2352x1568: 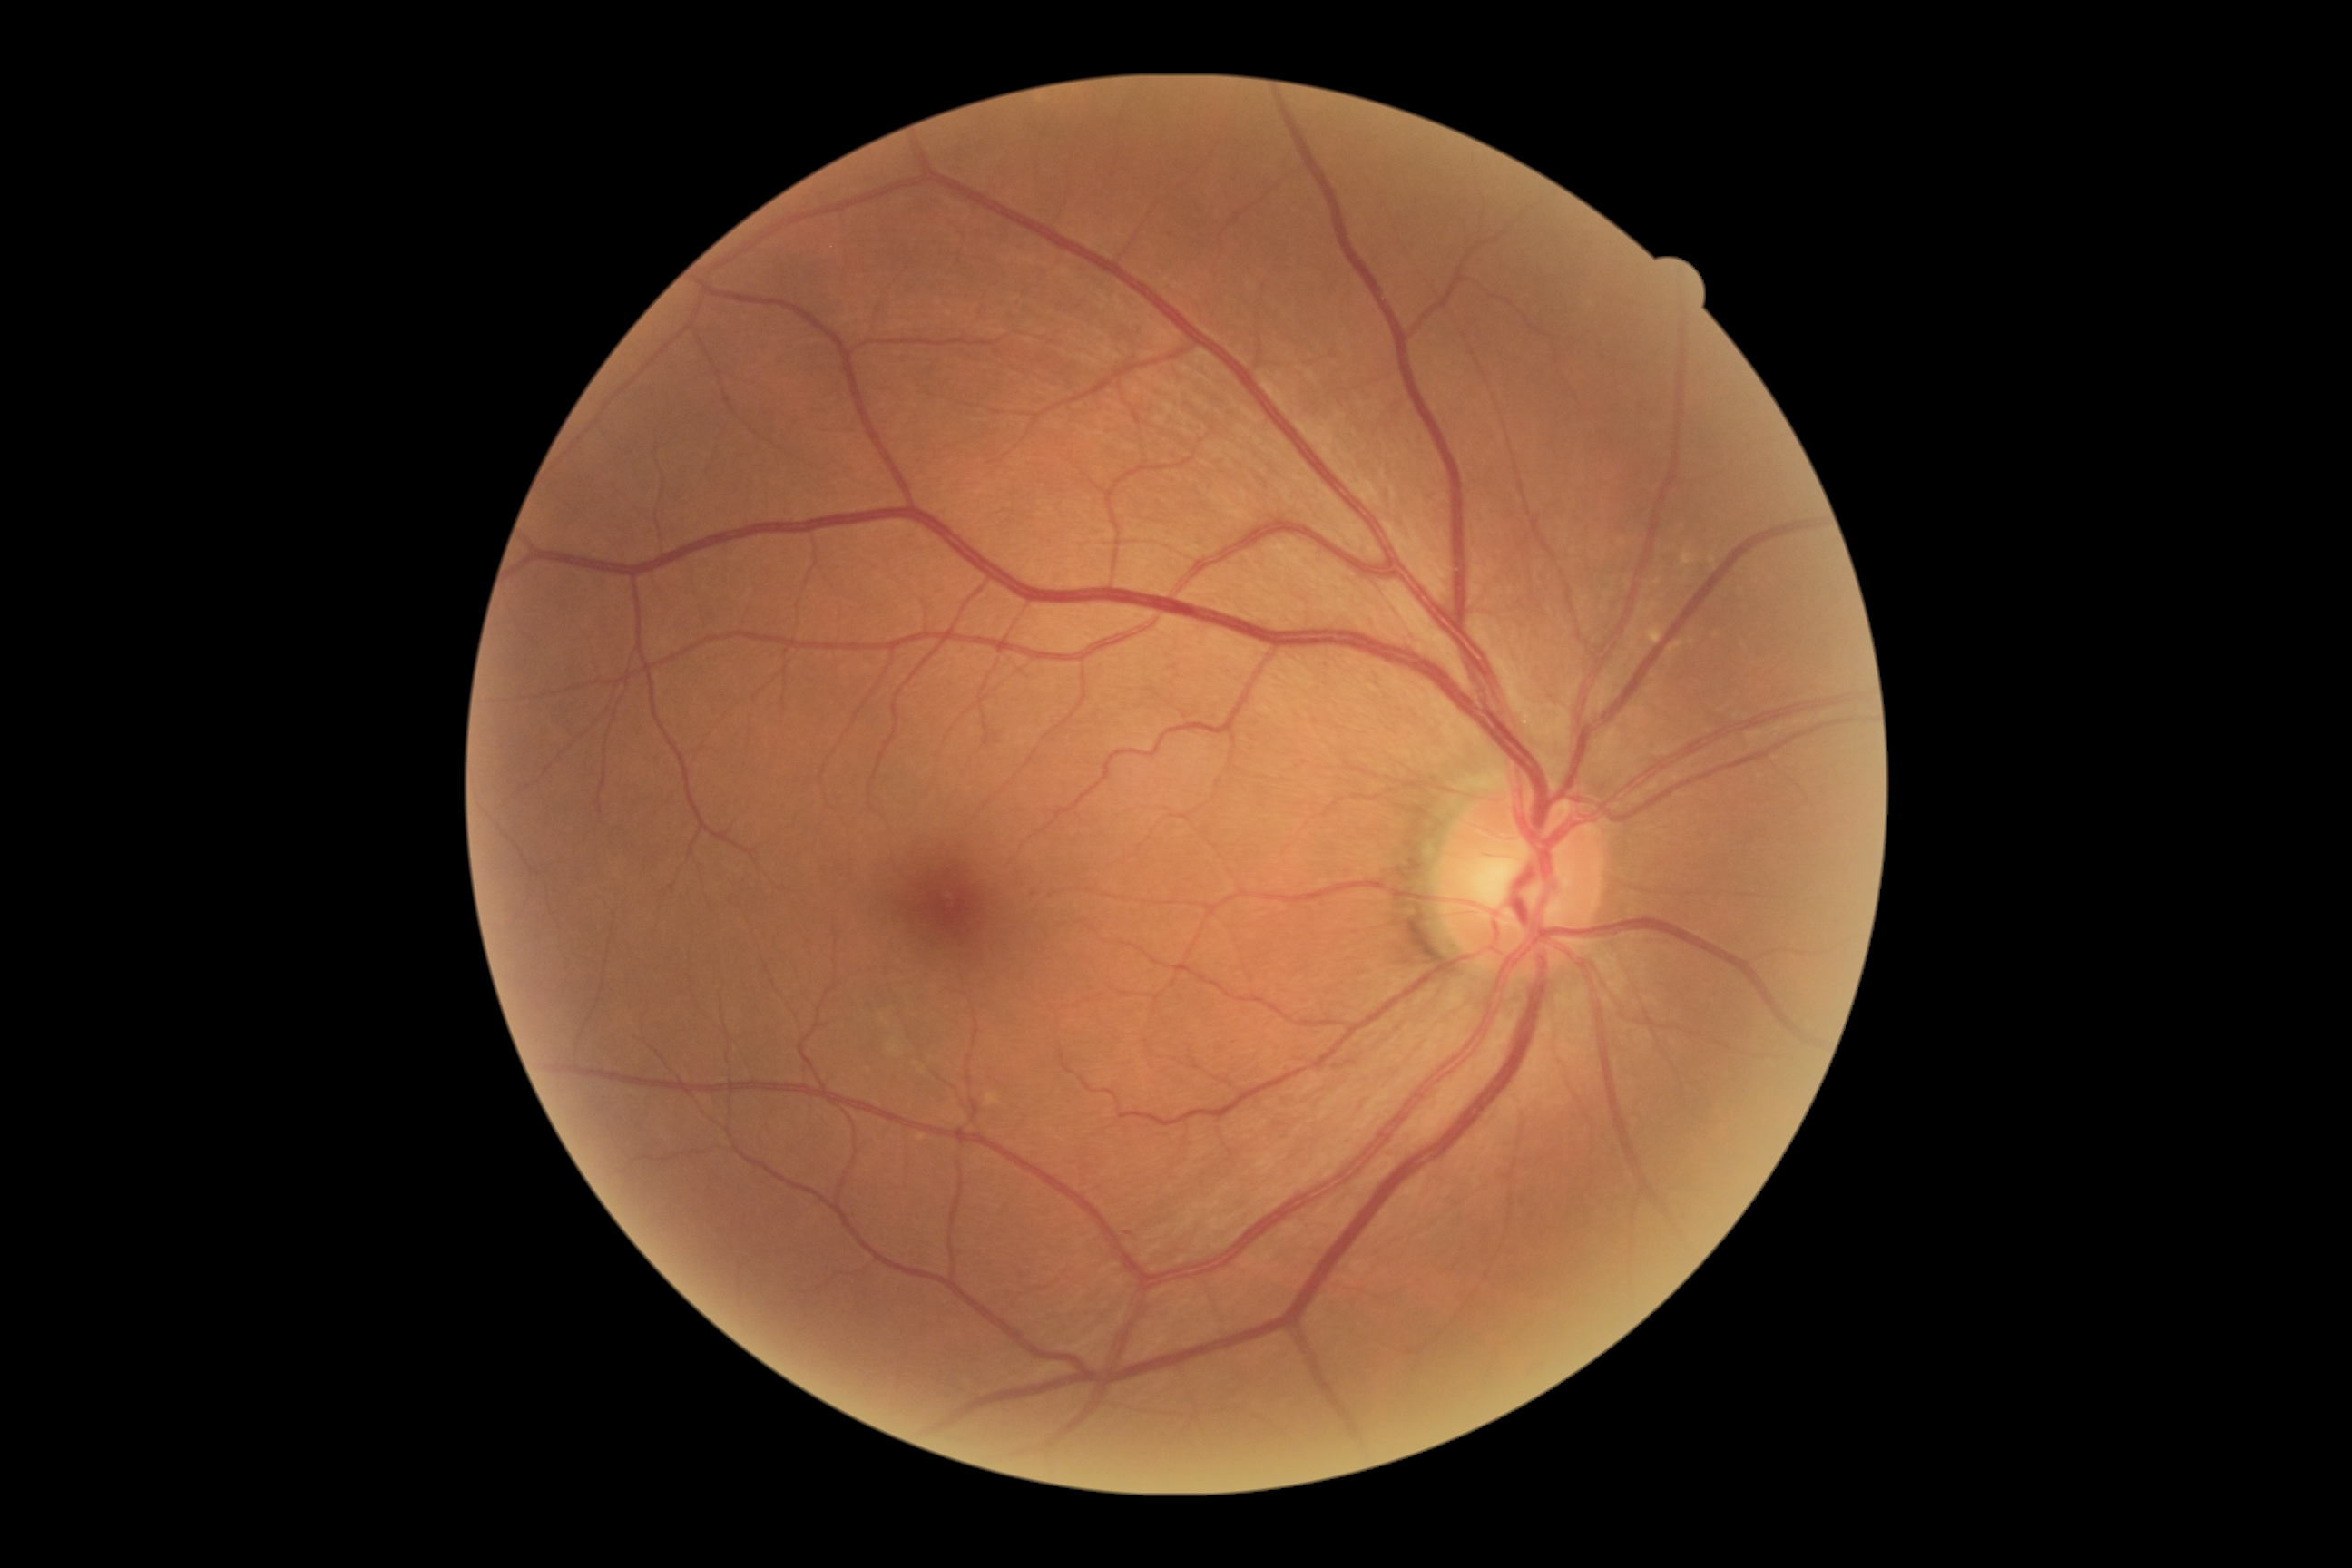

{
  "dr_grade": "grade 1"
}